Color fundus photograph
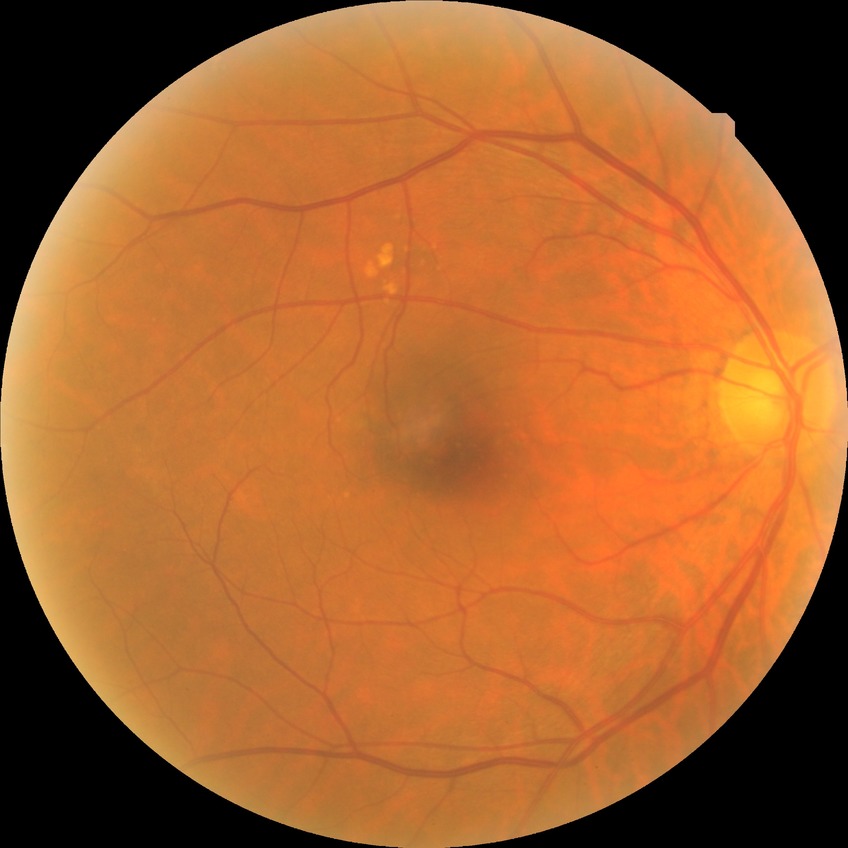

Davis grade is NDR. No apparent diabetic retinopathy.